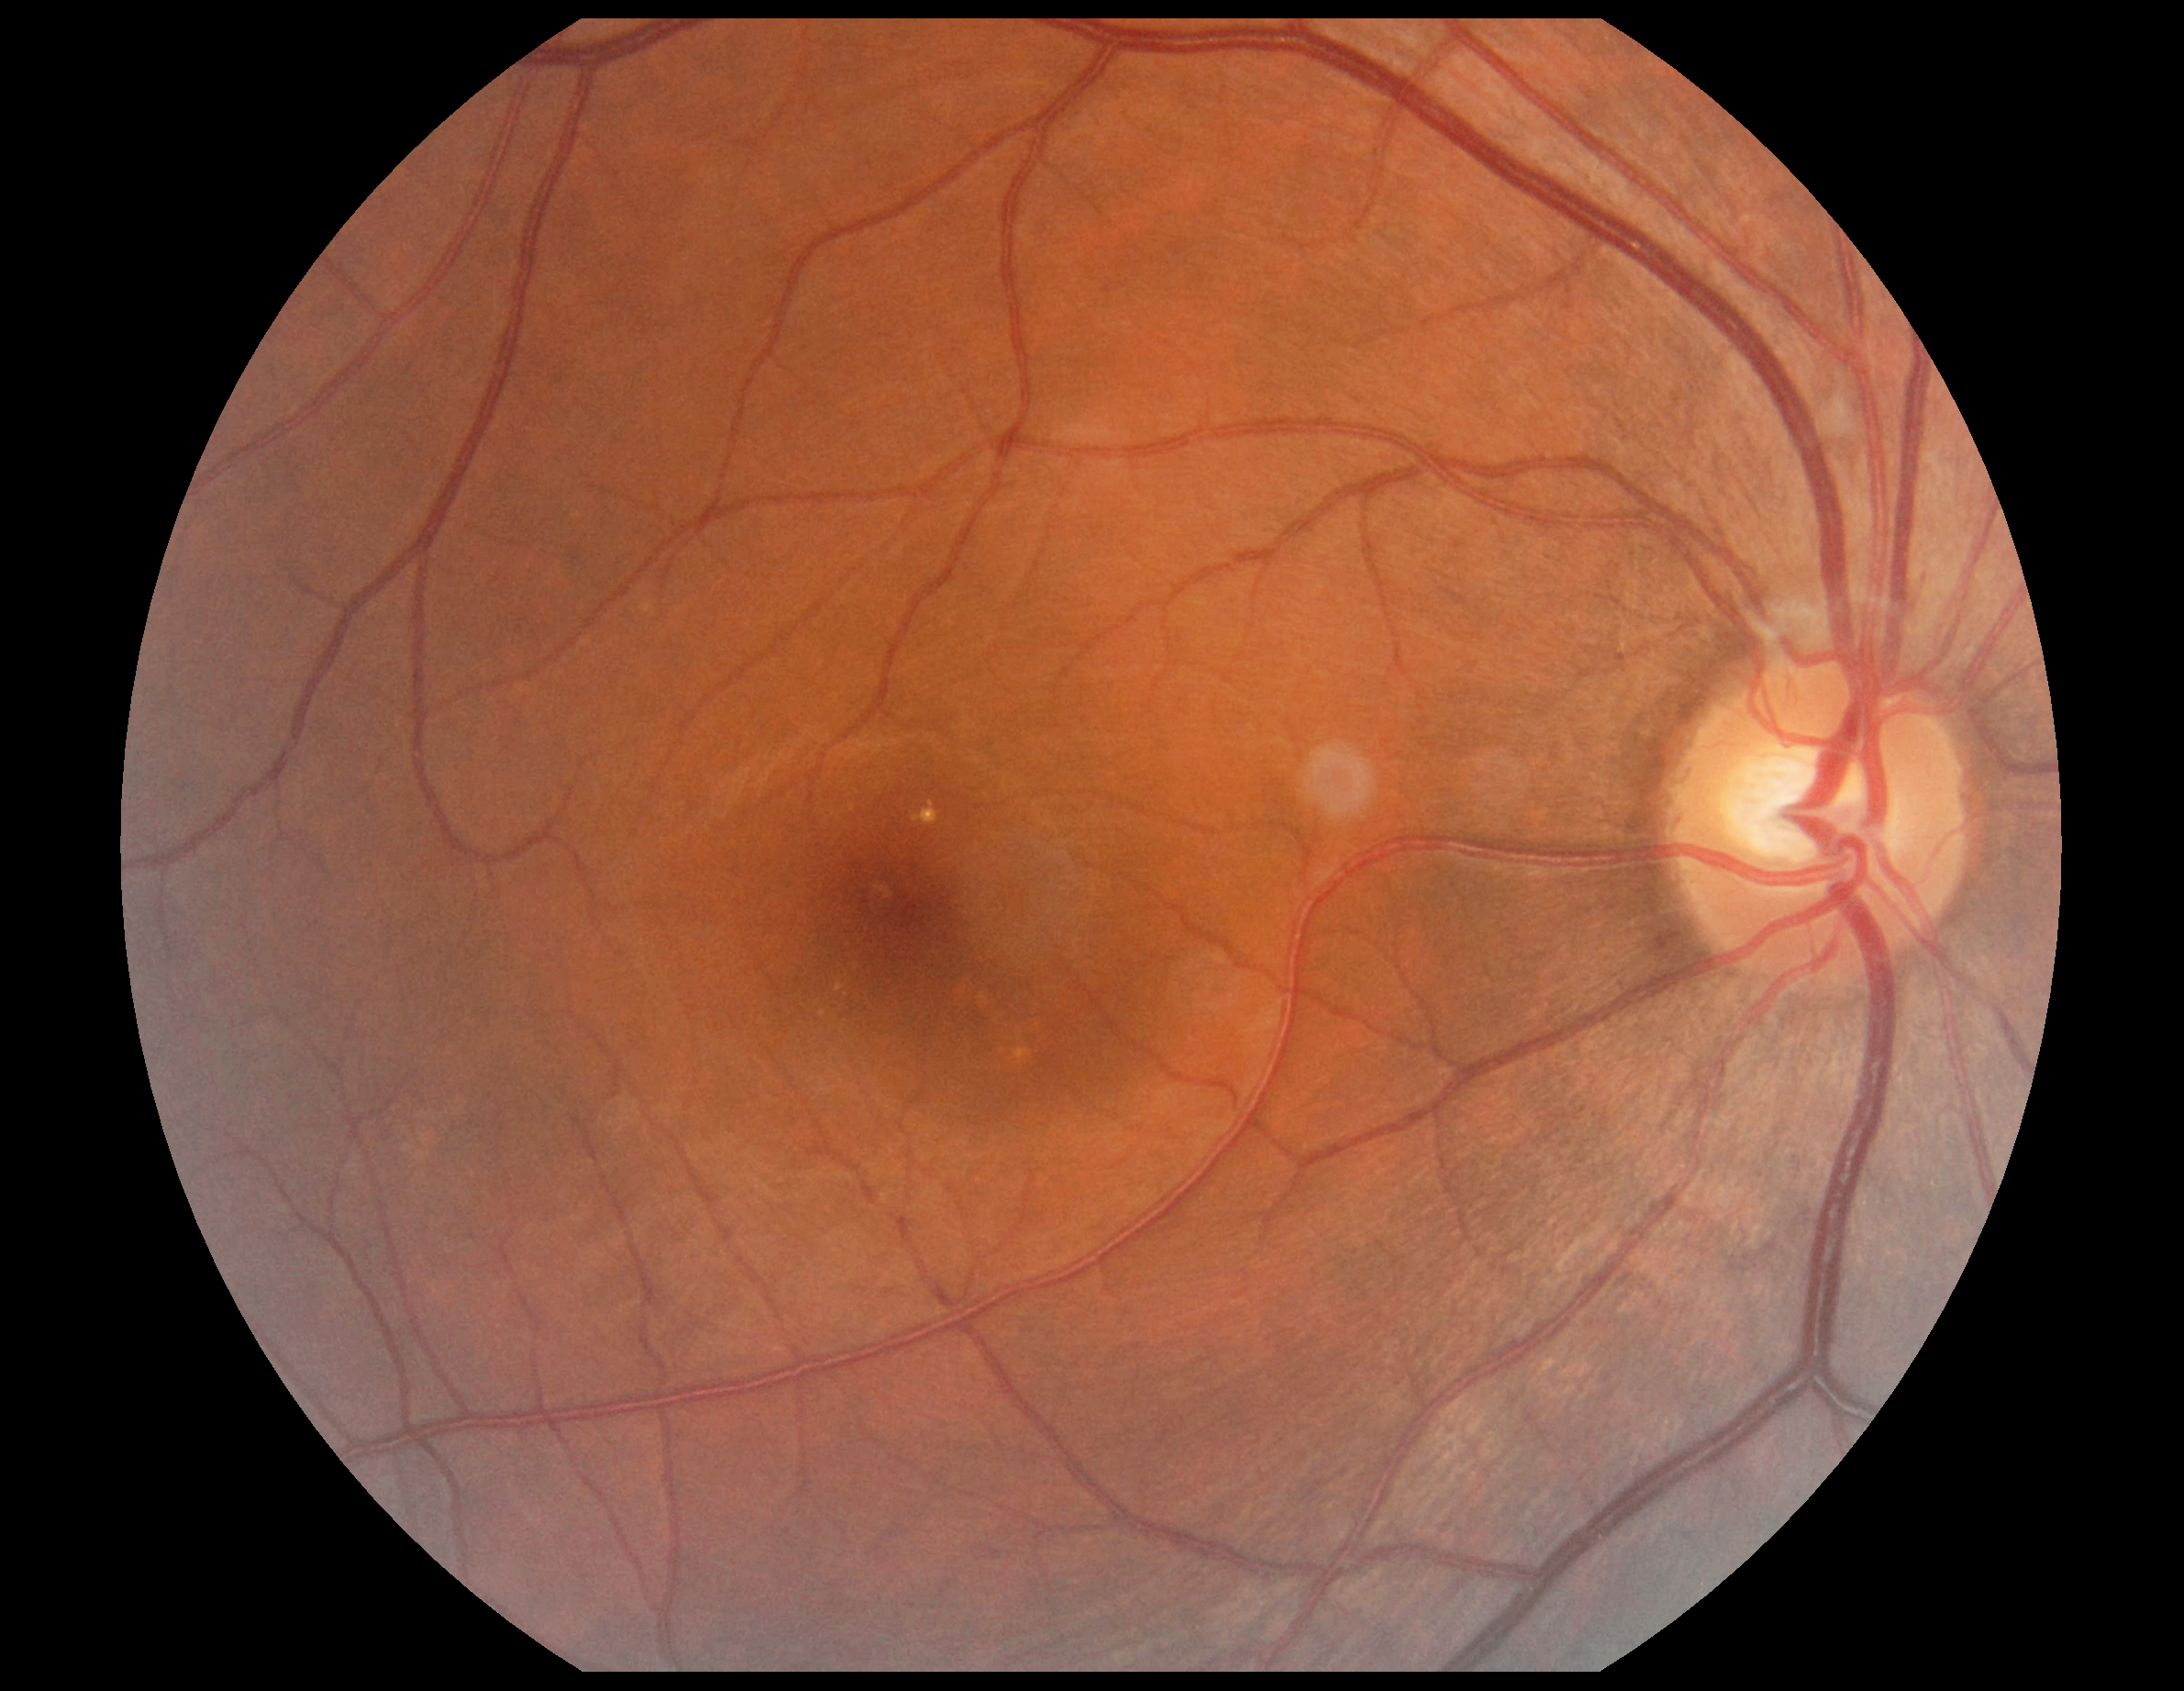

retinopathy grade: no apparent diabetic retinopathy (0), DR impression: negative for DR.